Remidio FOP fundus camera
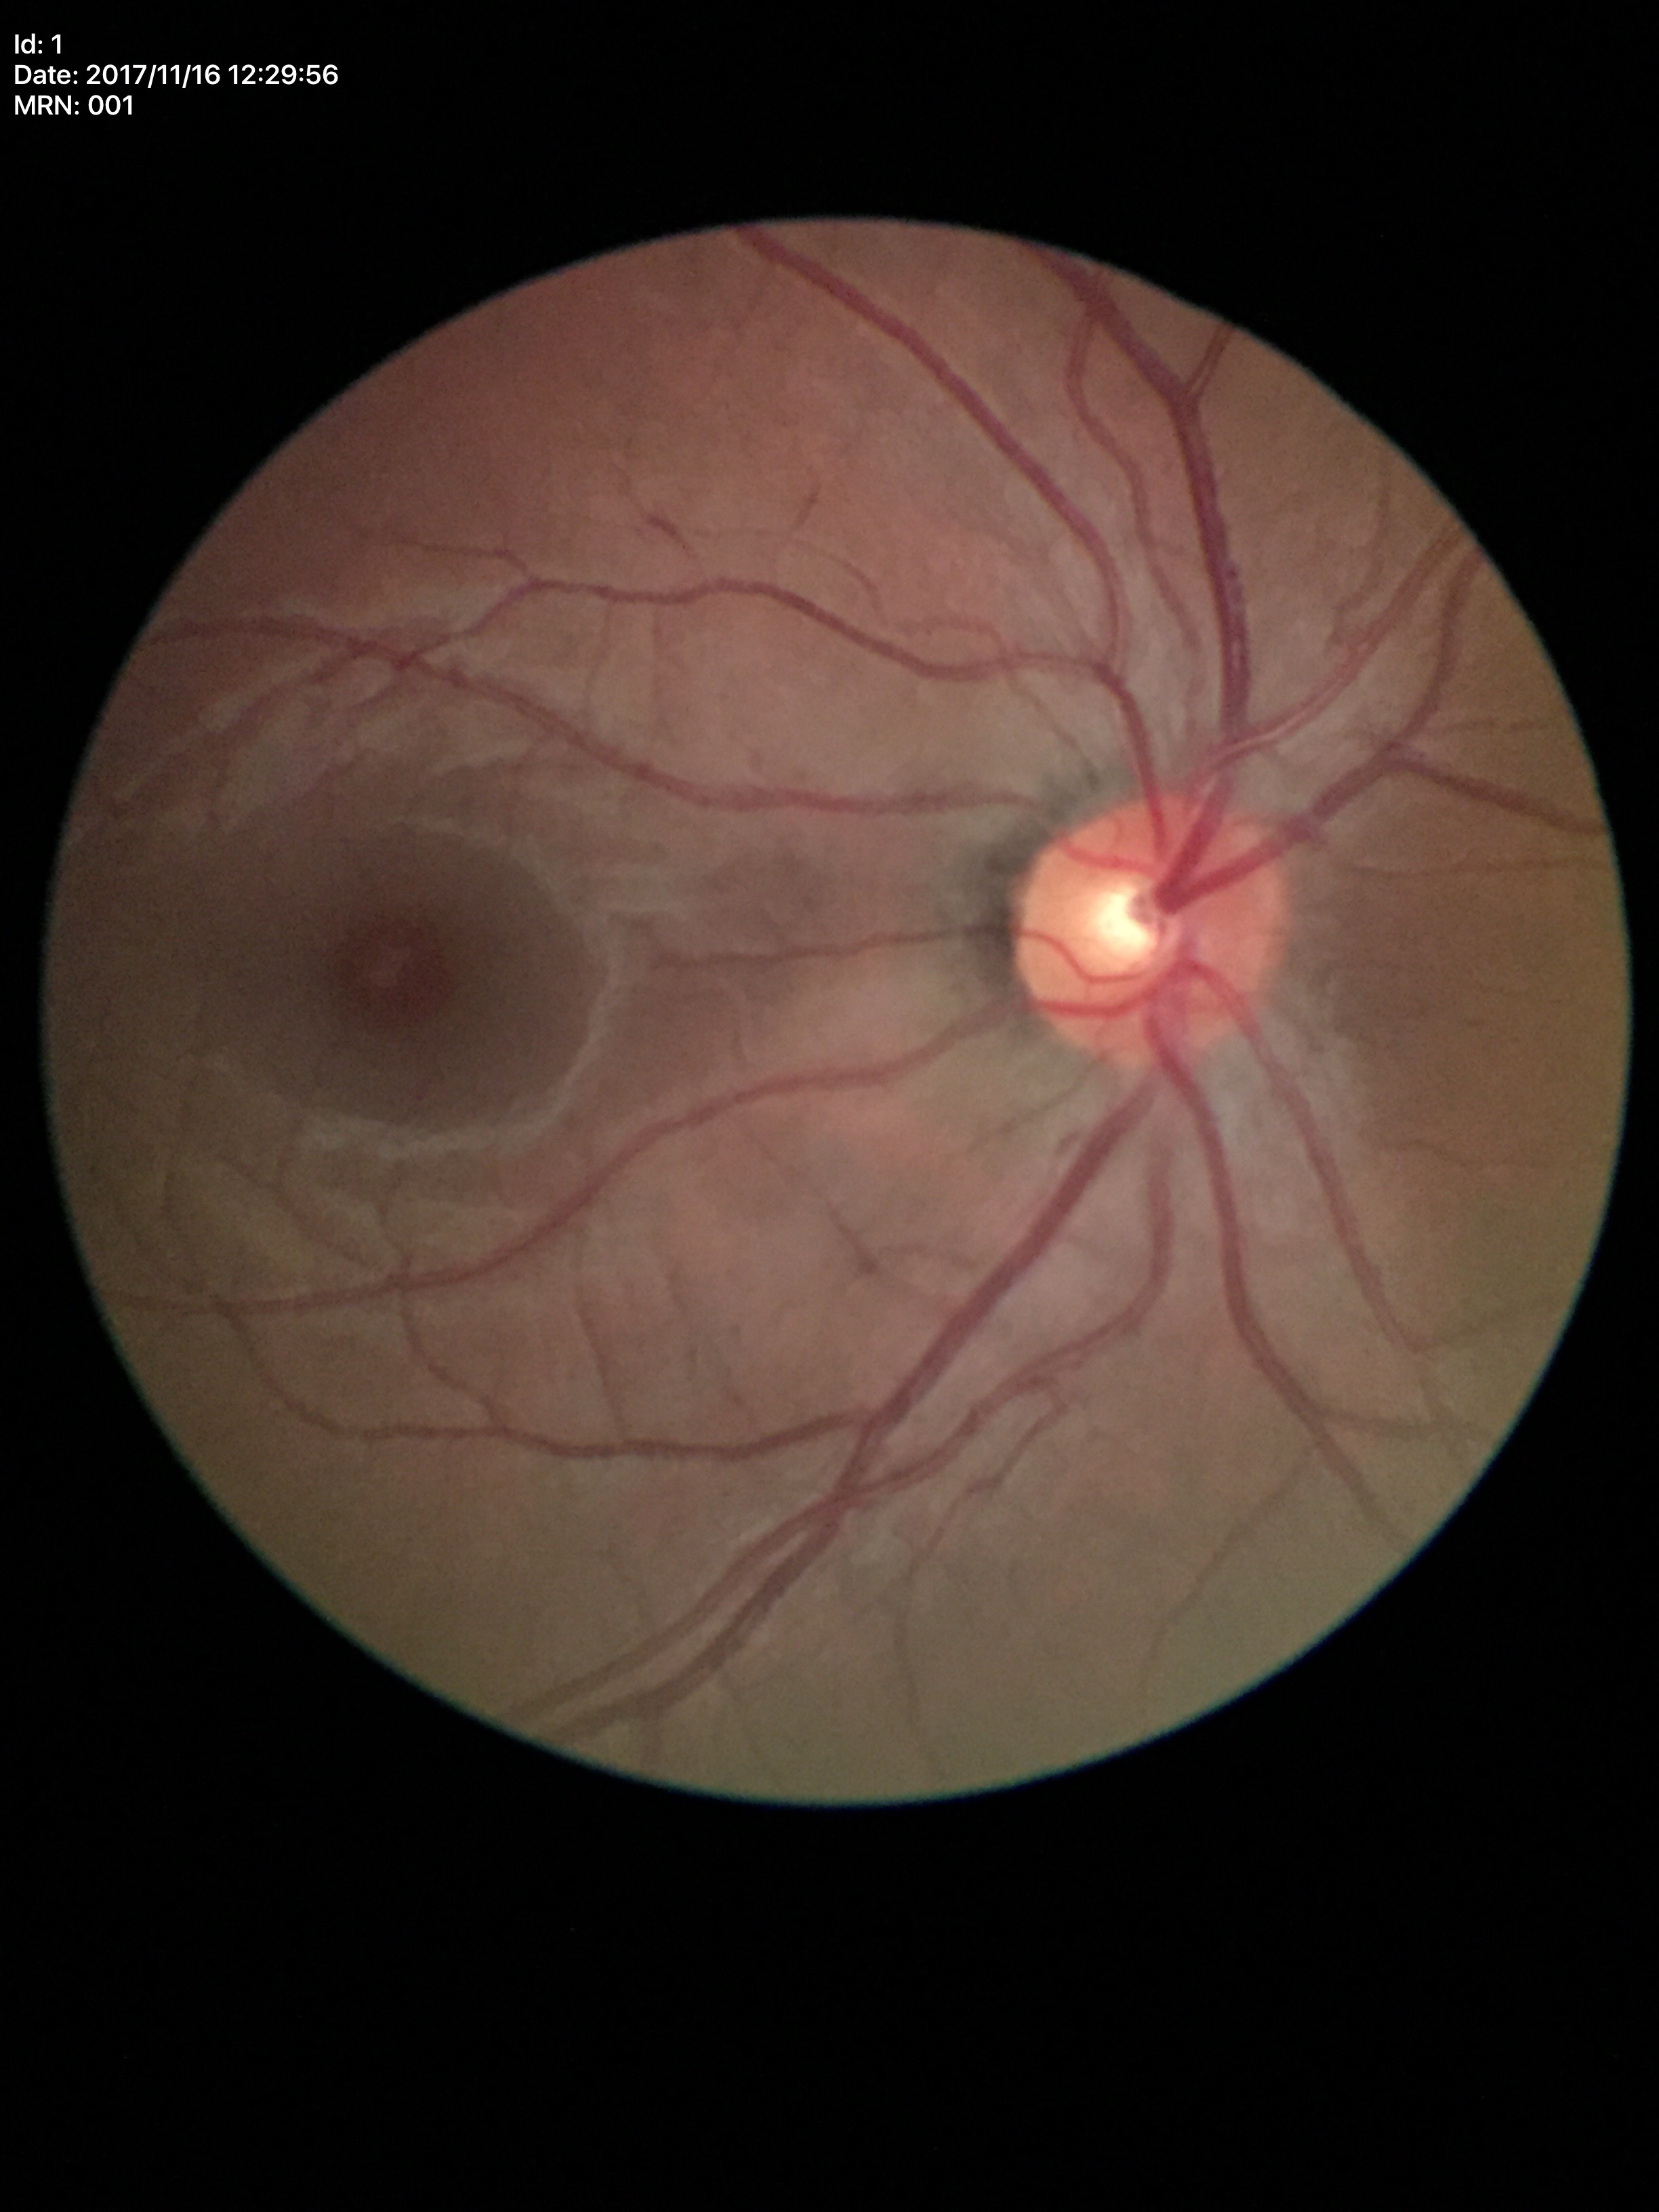 Glaucoma impression: not suspect (unanimous normal call). Vertical C/D ratio: 0.43. Area cup-disc ratio of 0.18.